Disc-centered field
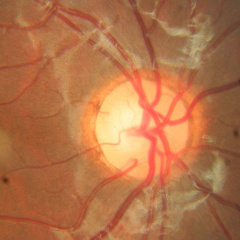 Optic disc photograph demonstrating no glaucomatous findings.